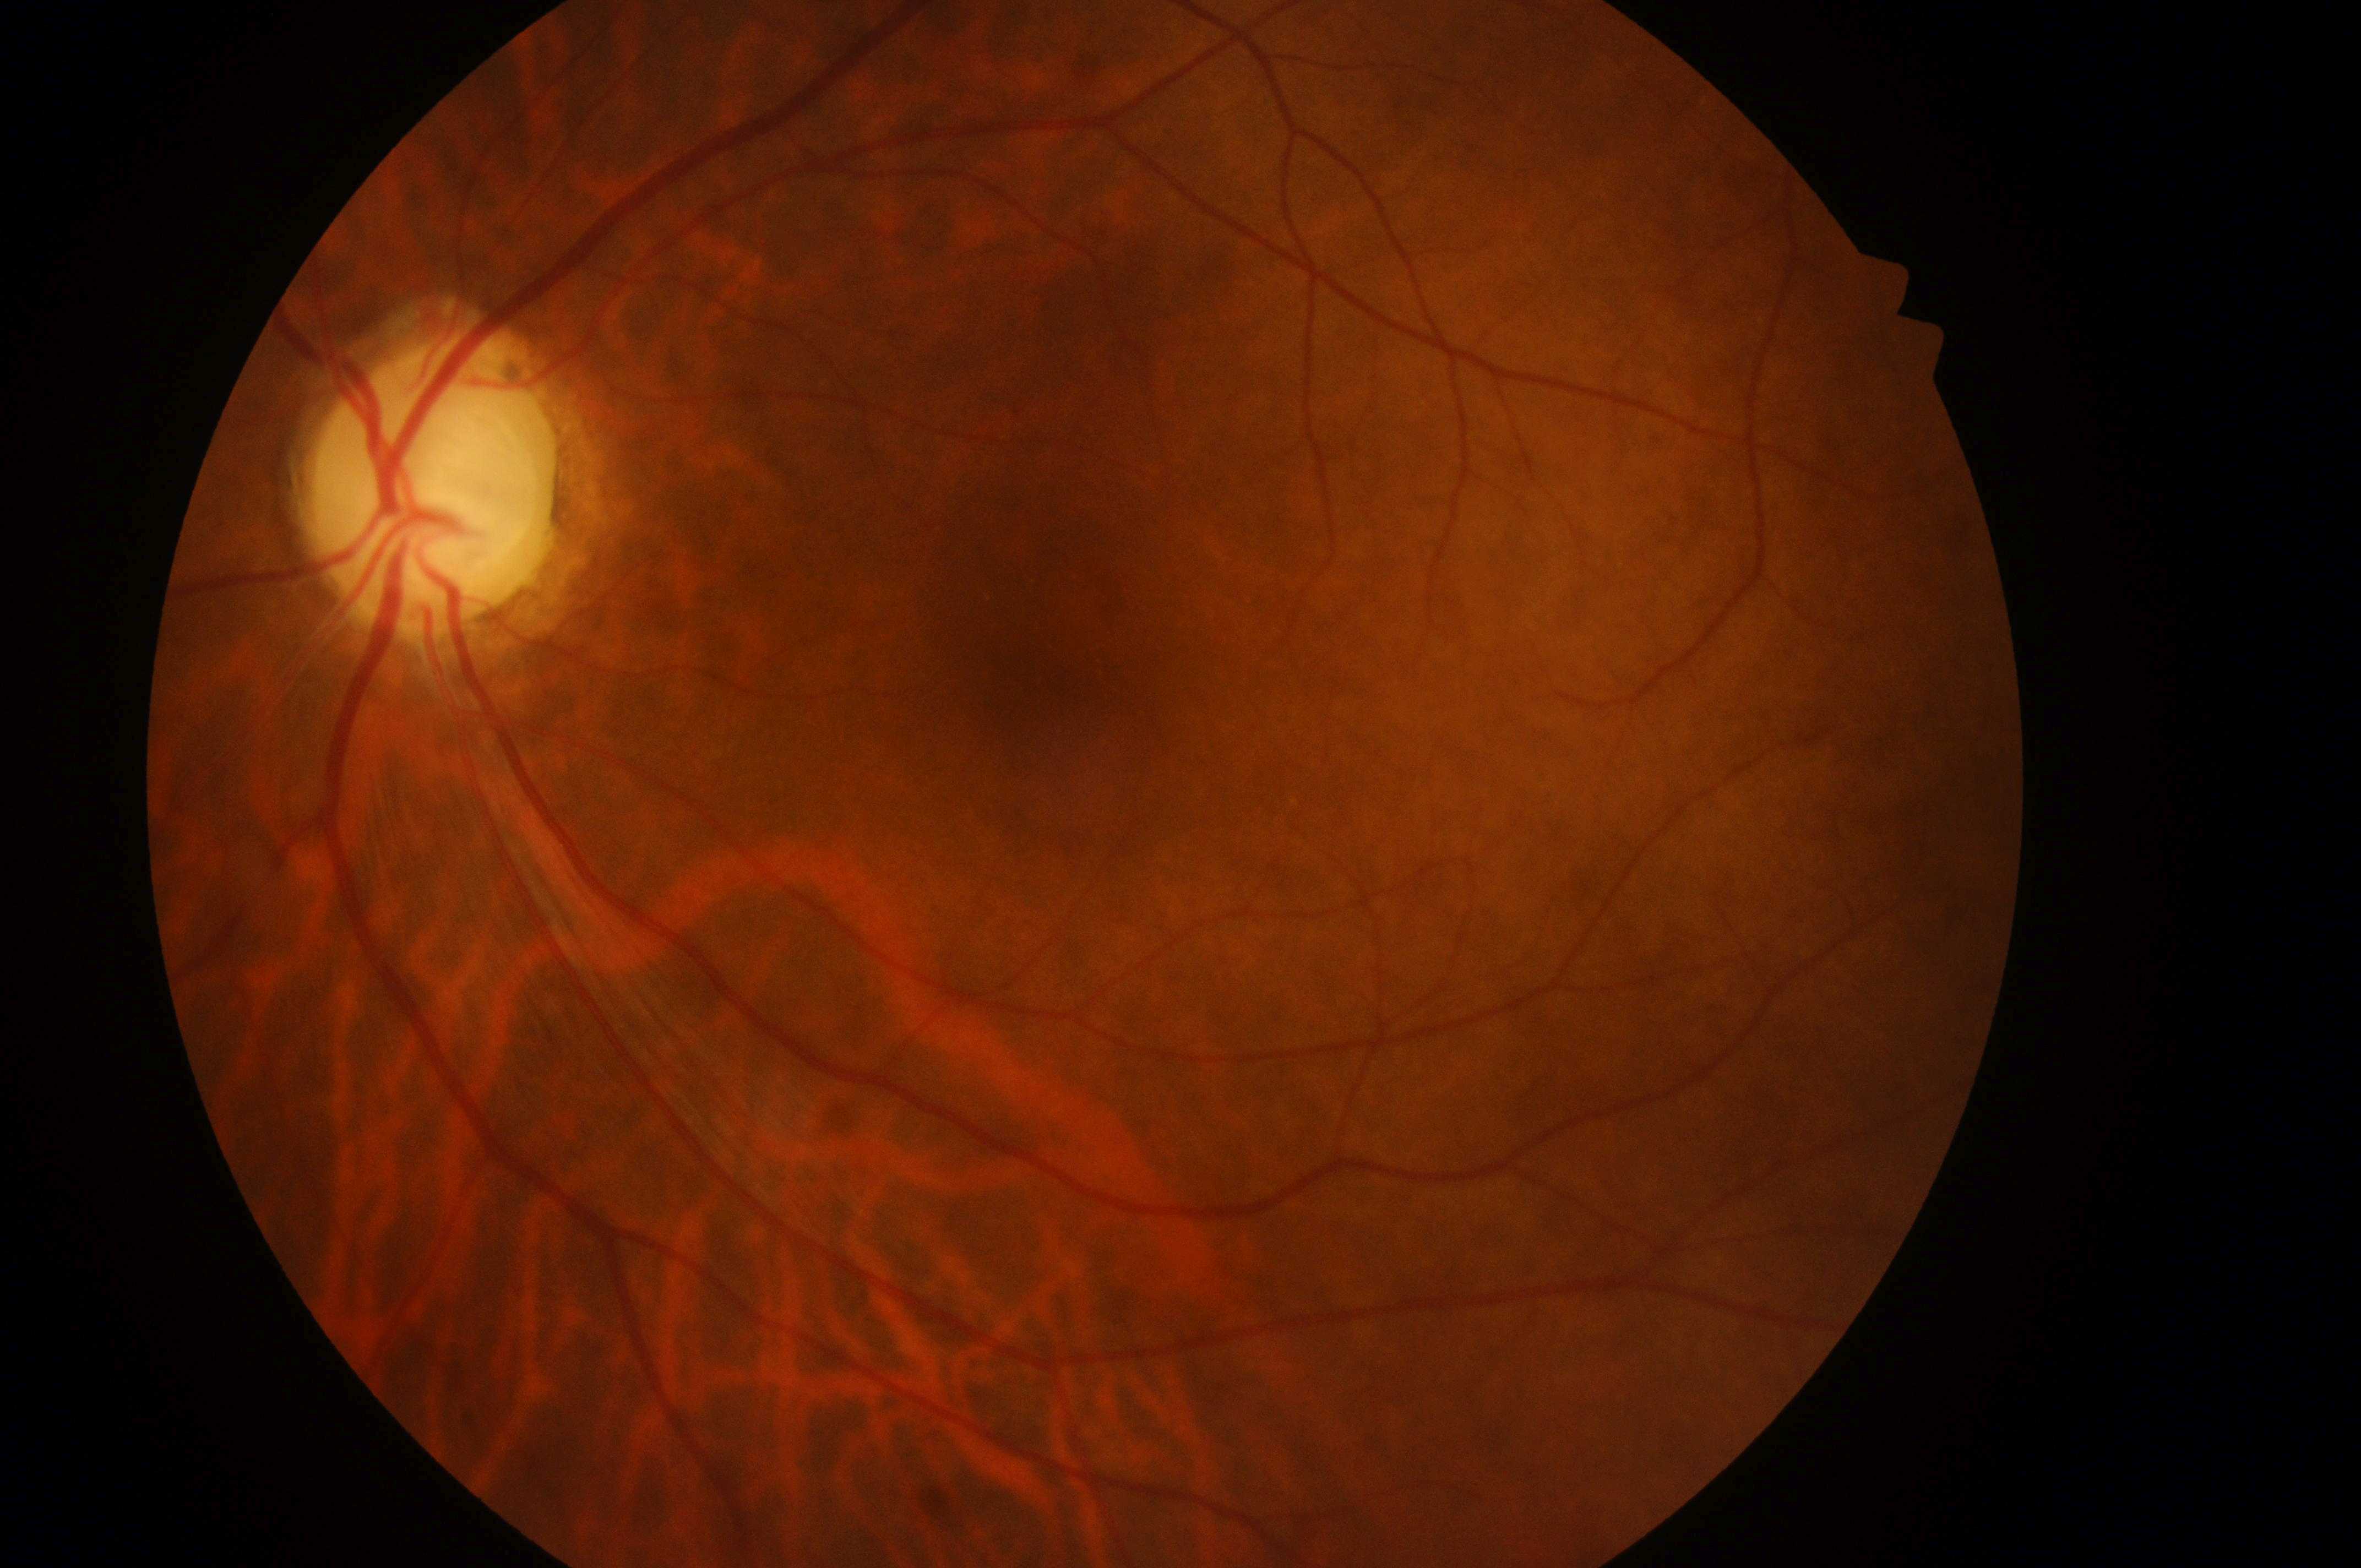

disc center = 427px, 494px
DR grade = 0 (no apparent retinopathy) — no visible signs of diabetic retinopathy
DME risk = no risk (grade 0) — no apparent hard exudates
macula center = 1031px, 674px
laterality = left eye